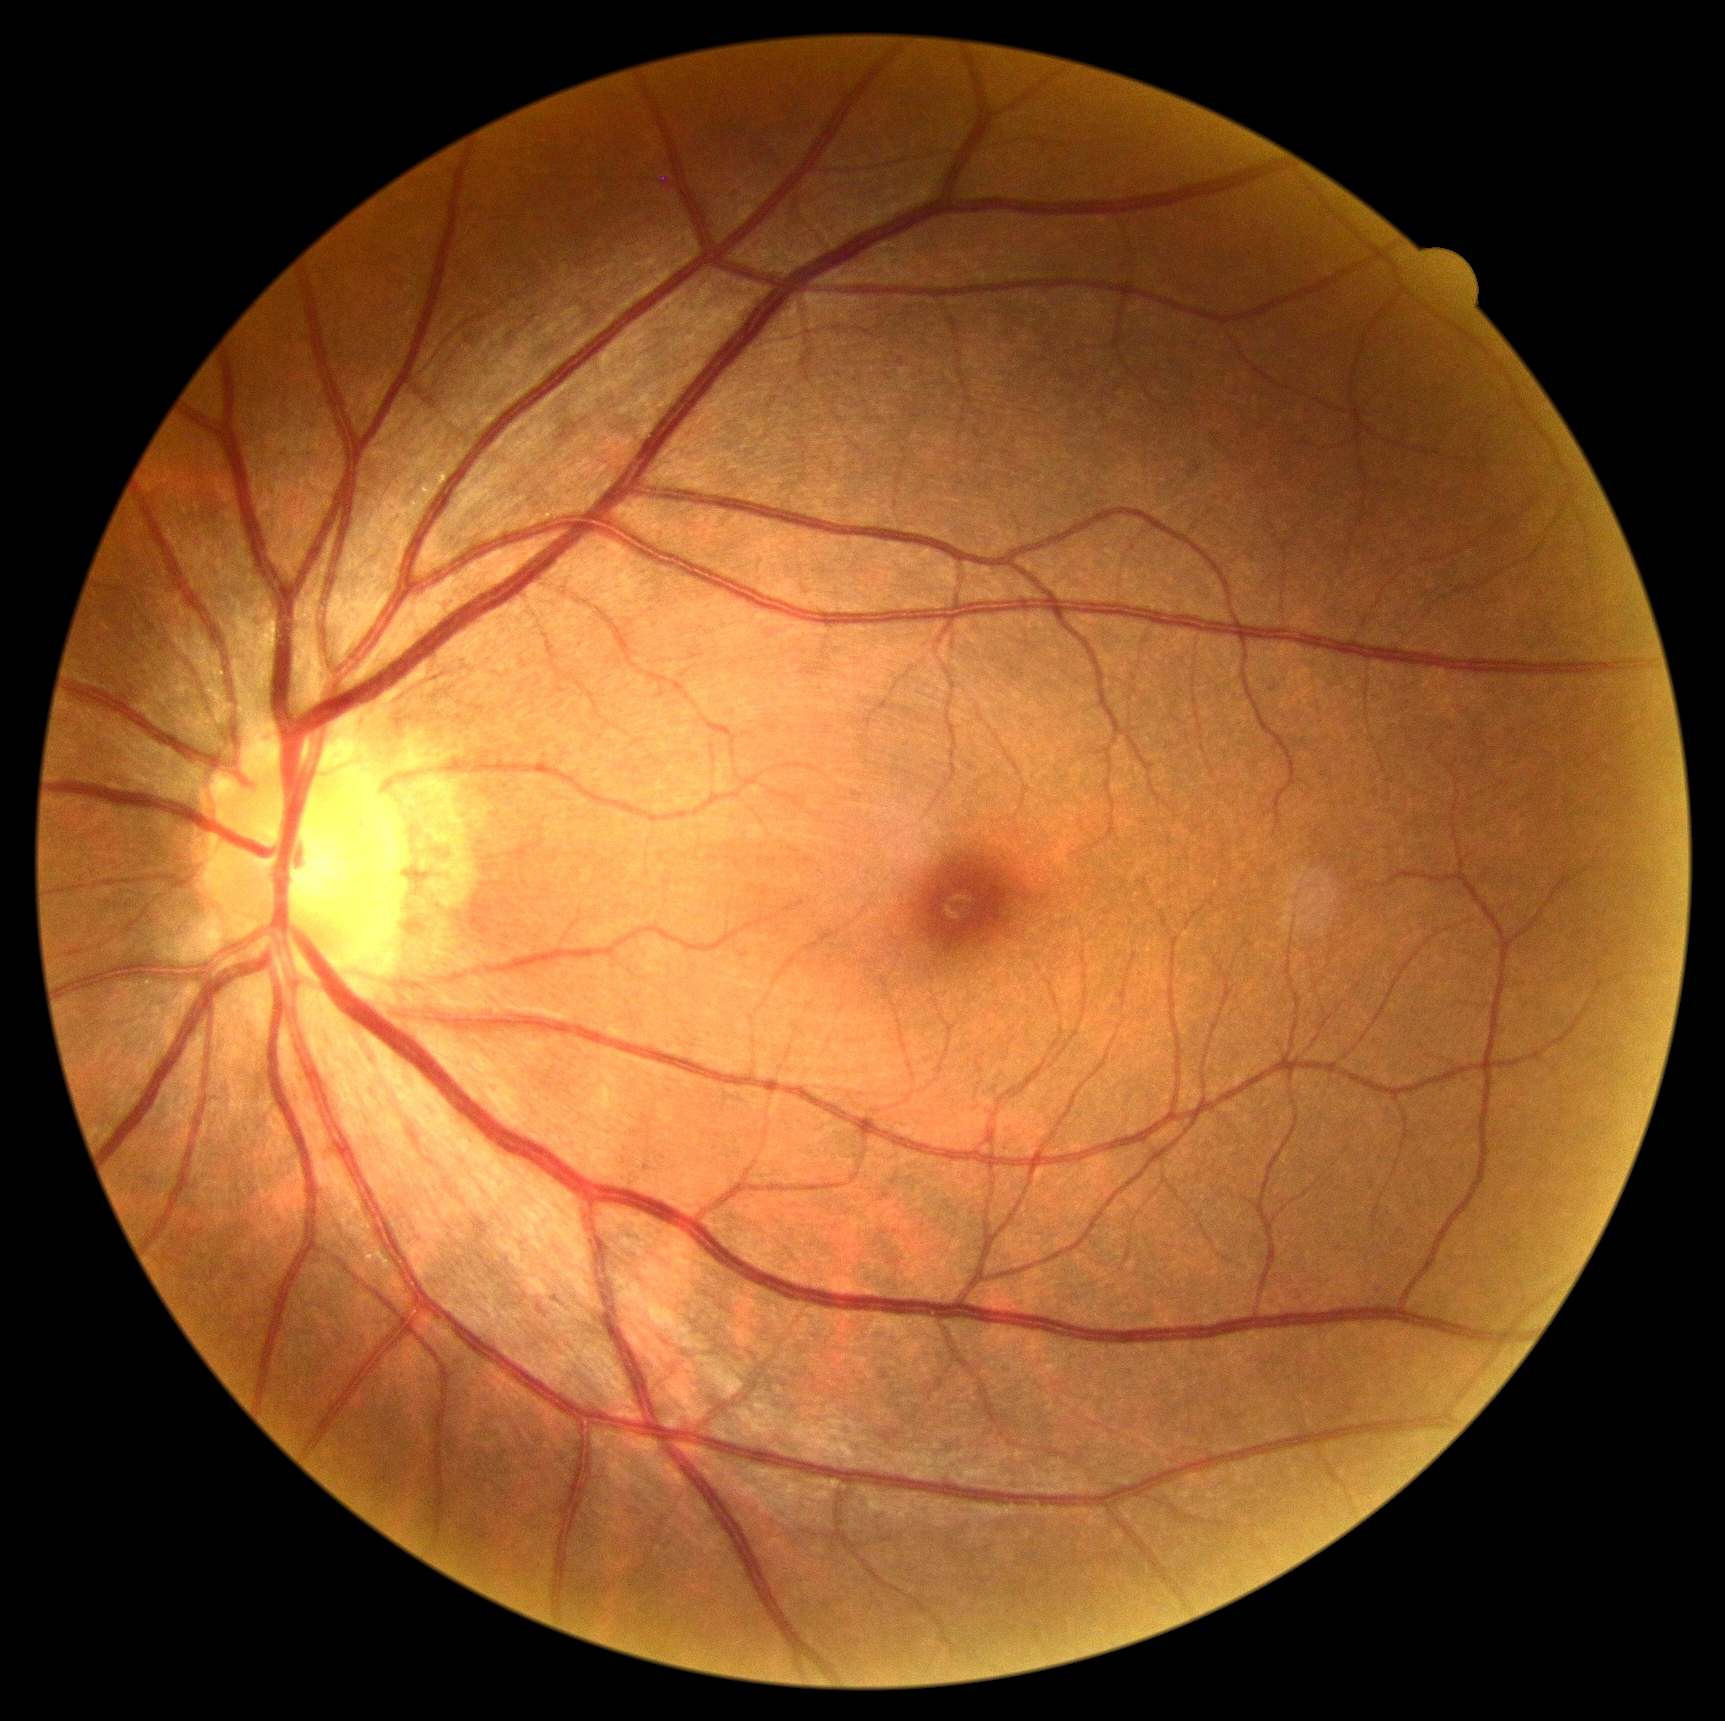
{
  "dr_grade": "0 — no visible signs of diabetic retinopathy"
}